45 degree fundus photograph:
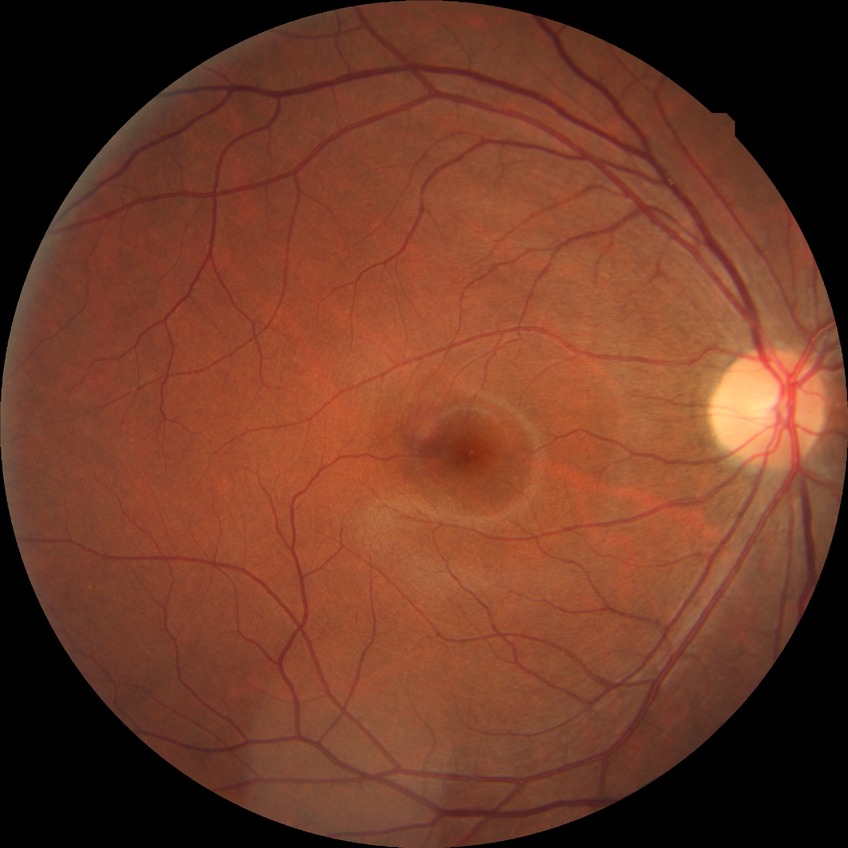

diabetic retinopathy stage = no diabetic retinopathy.